Pediatric retinal photograph (wide-field); 1440 x 1080 pixels; 130° field of view (Natus RetCam Envision): 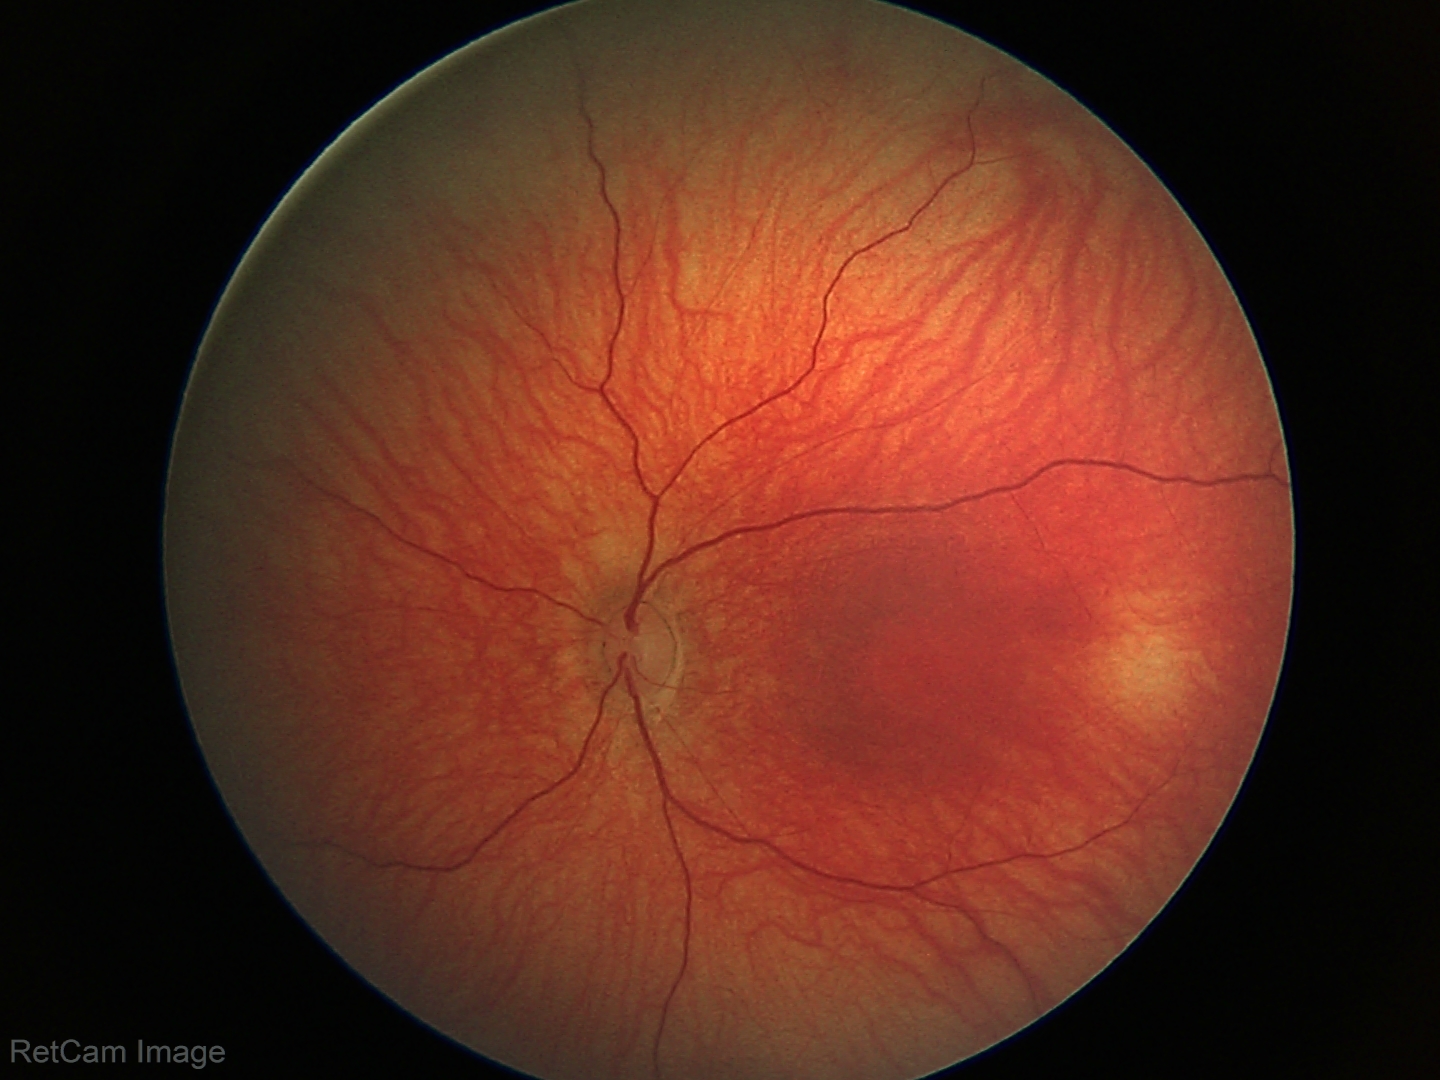 Screening examination diagnosed as physiological.